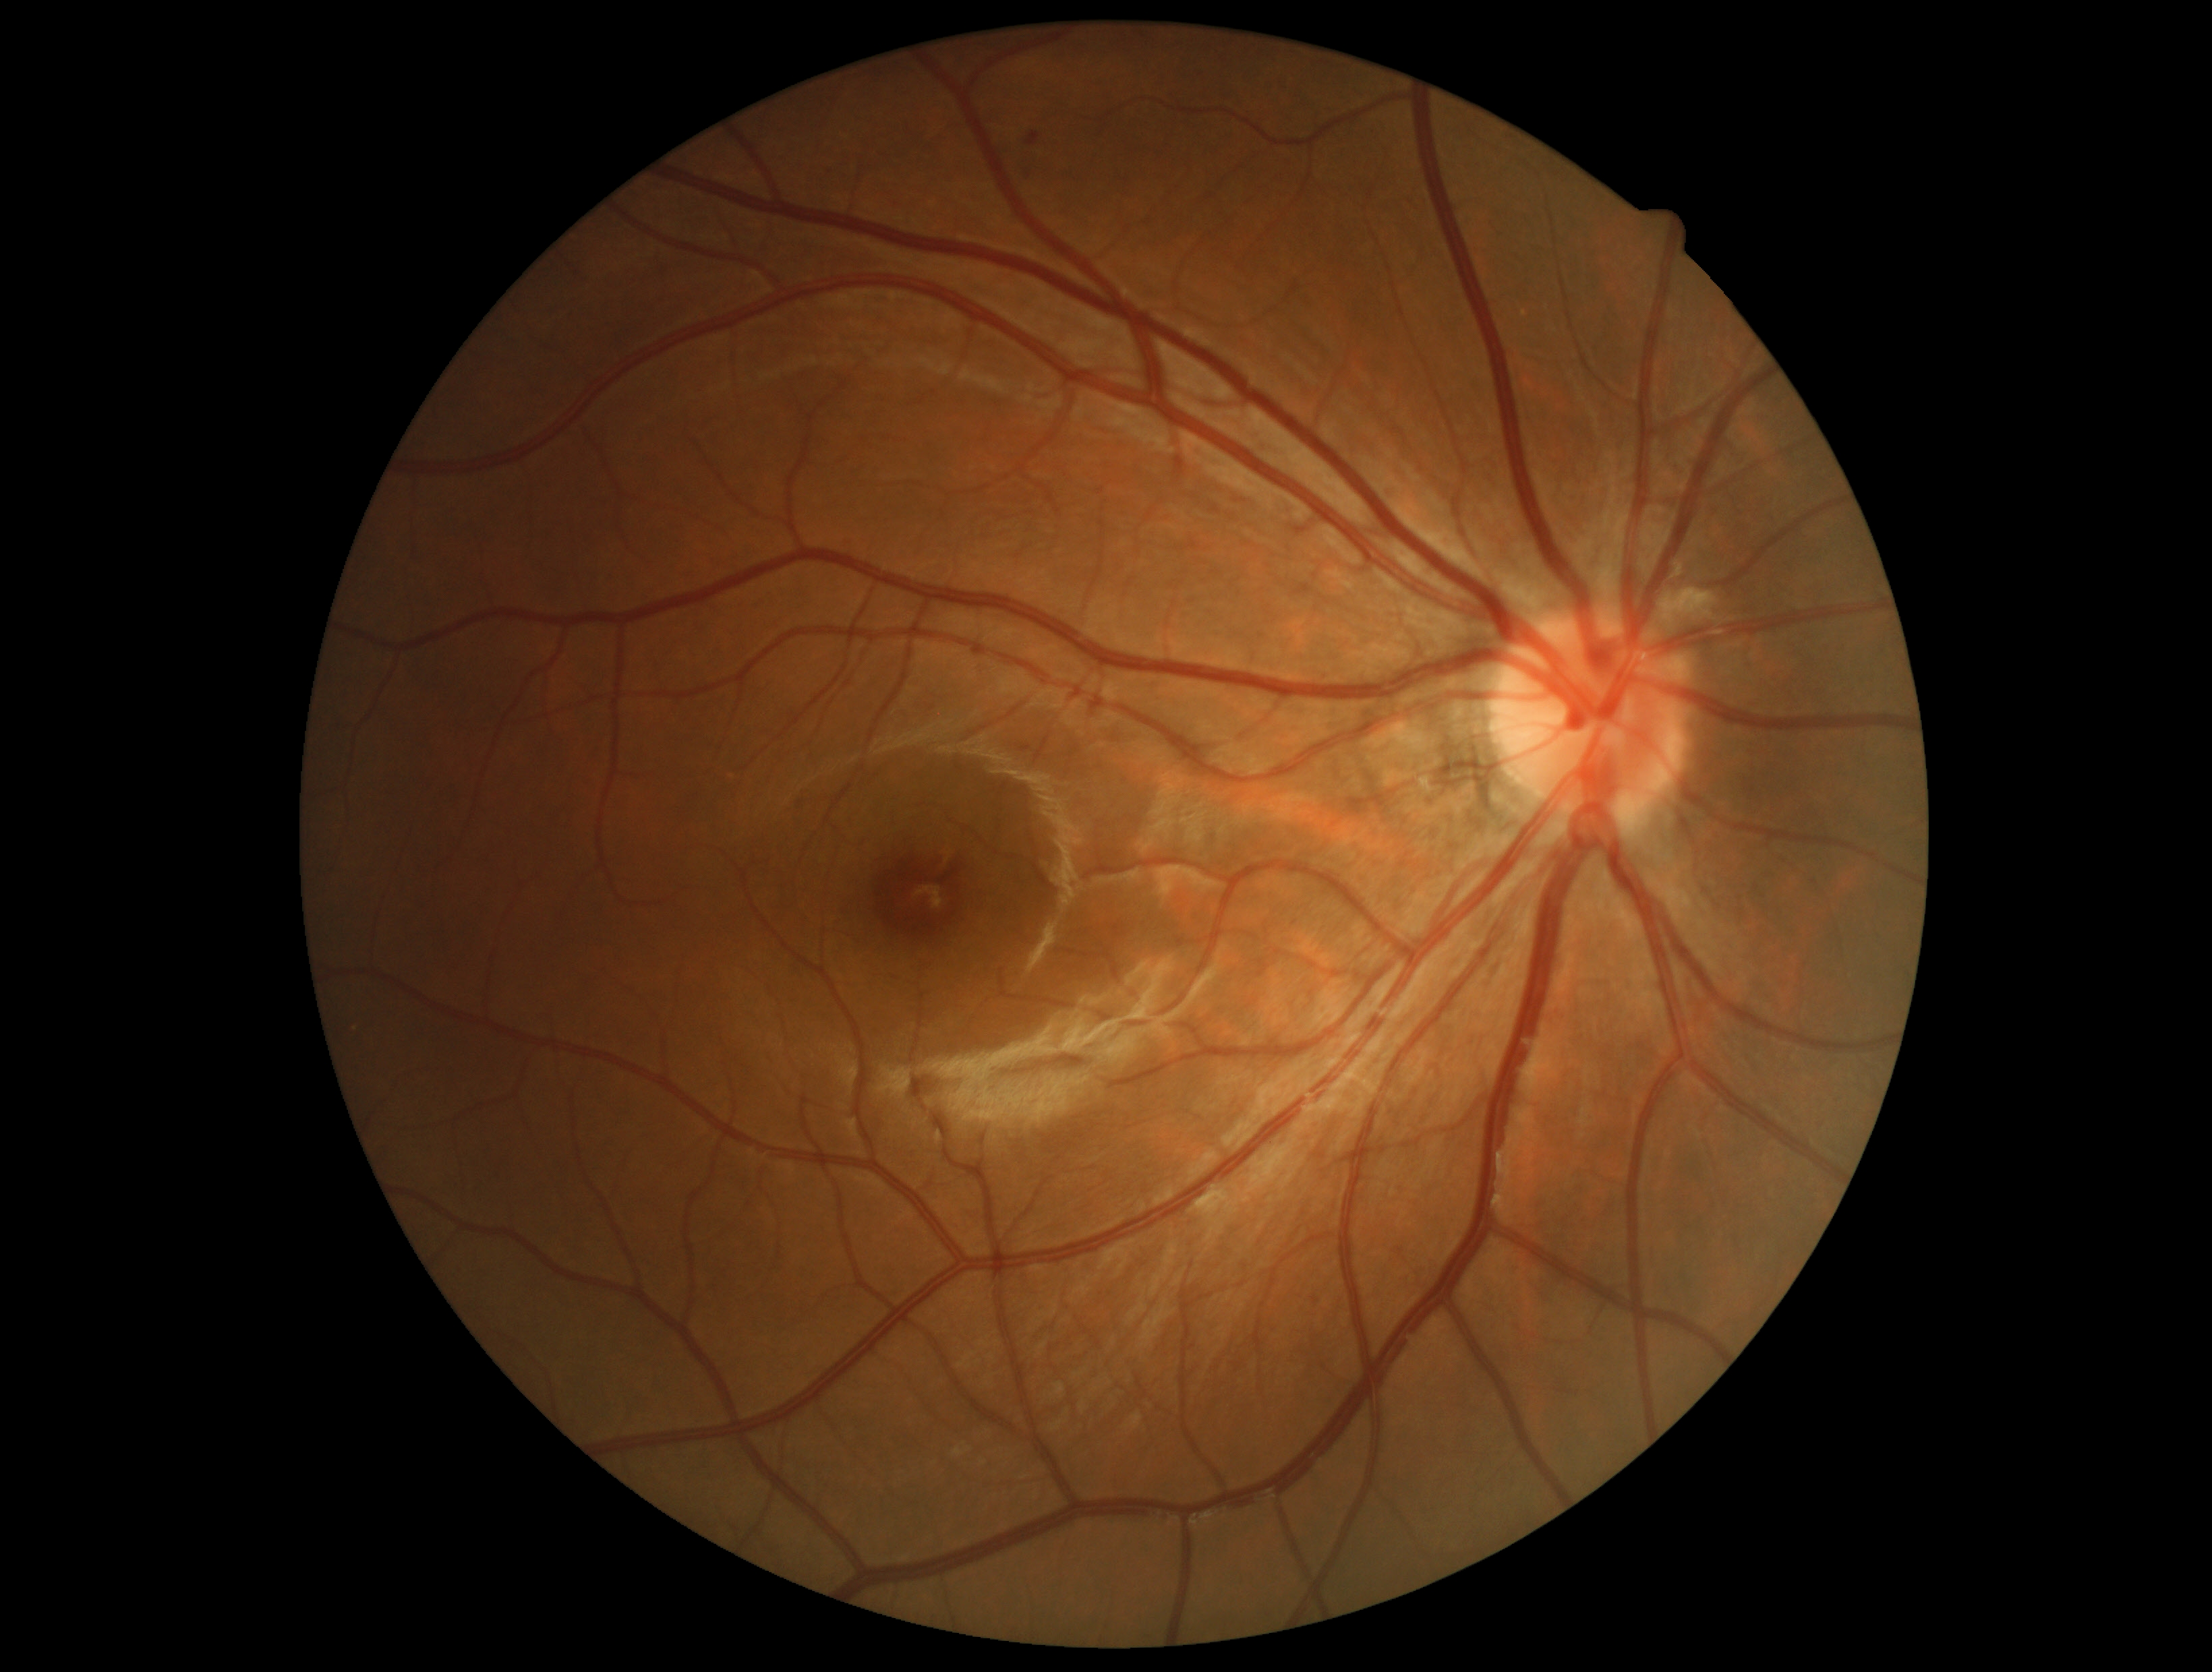
DR is grade 2 (moderate NPDR).